1240 x 1240 pixels · infant wide-field retinal image: 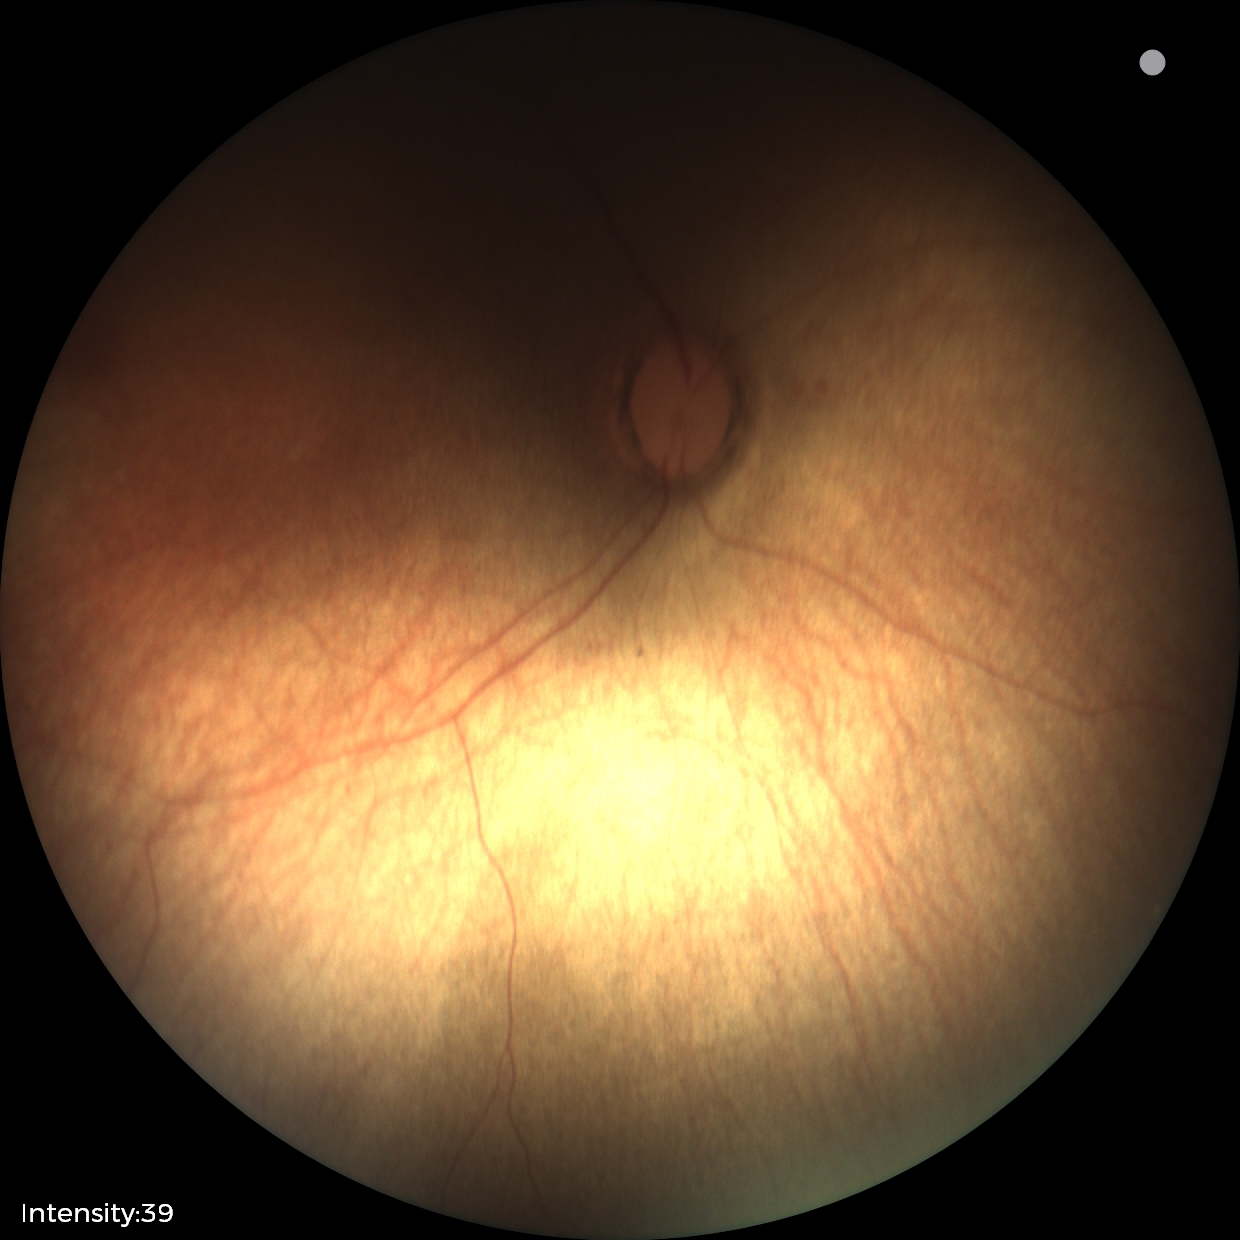

Screening examination with no abnormal retinal findings.